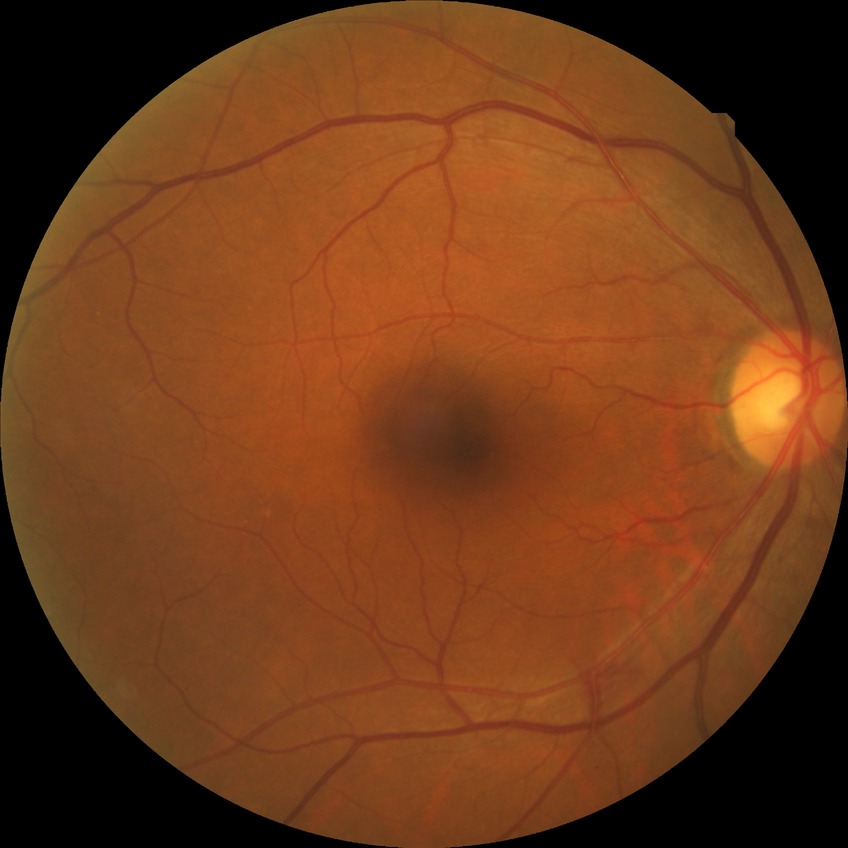 Modified Davis grading: no diabetic retinopathy.